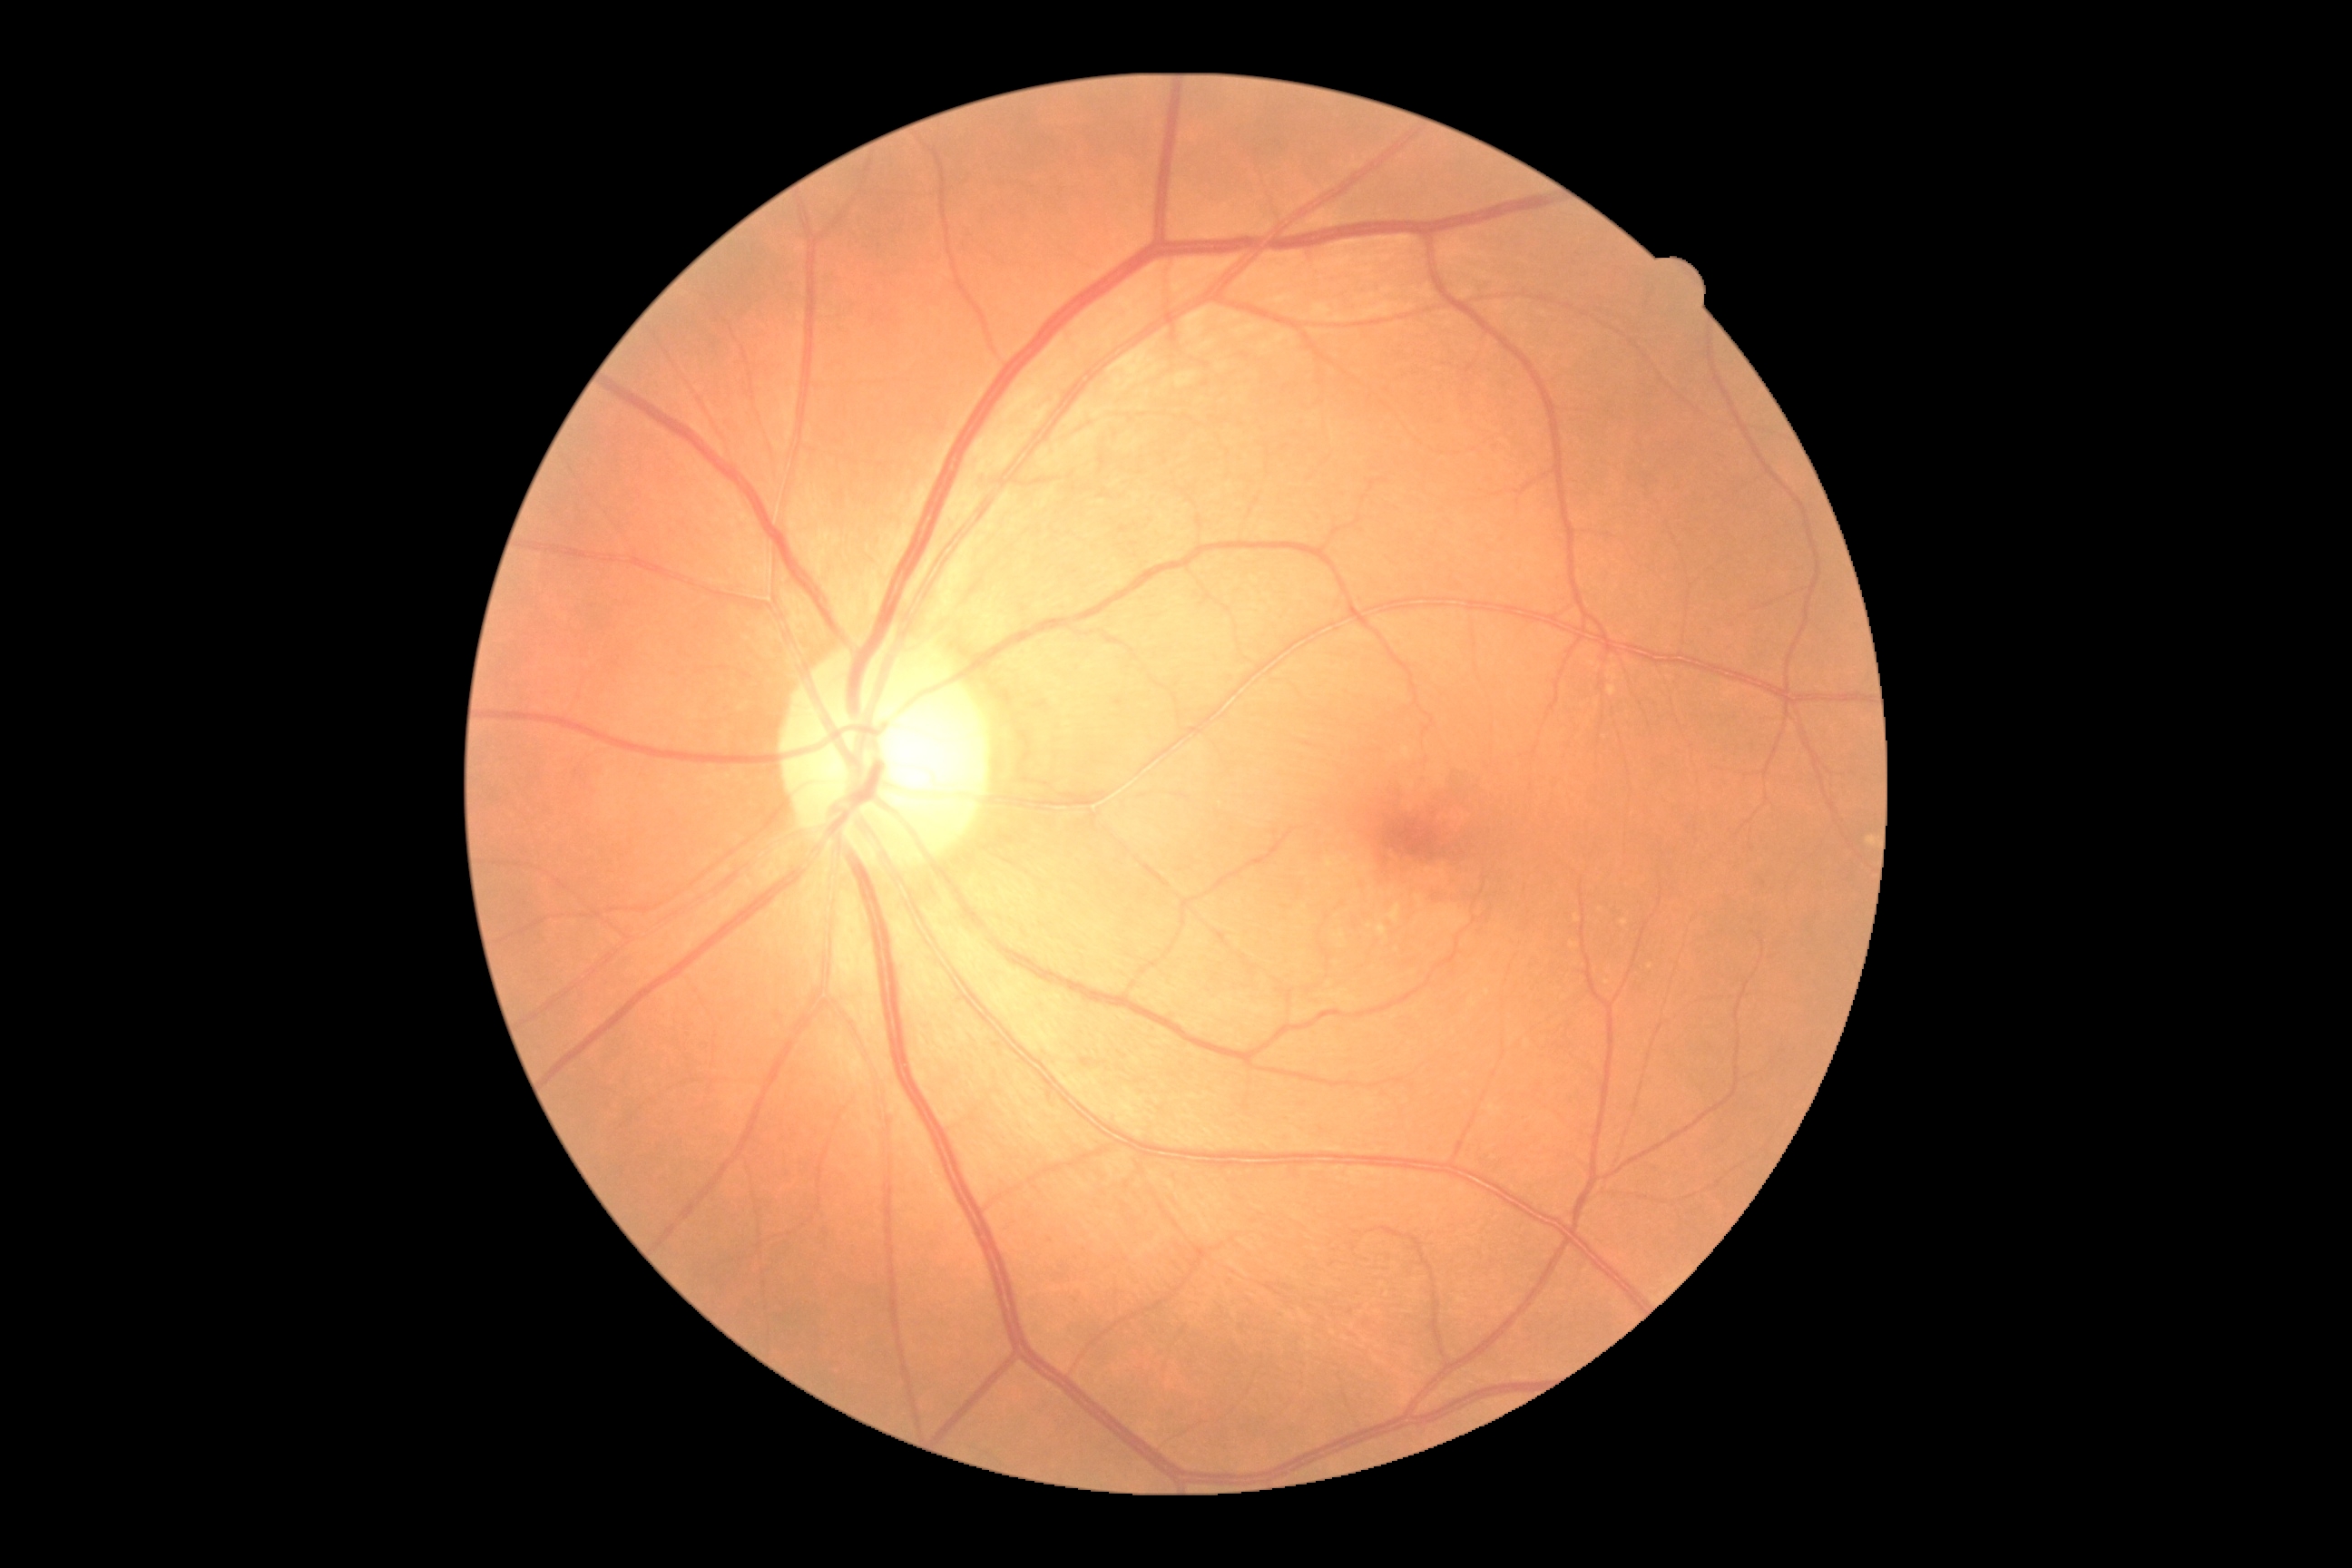 Diabetic retinopathy severity: grade 0 (no apparent retinopathy).